Fundus photograph cropped around the optic nerve head. Captured on a Topcon TRC retinal camera. Image size 478x478: 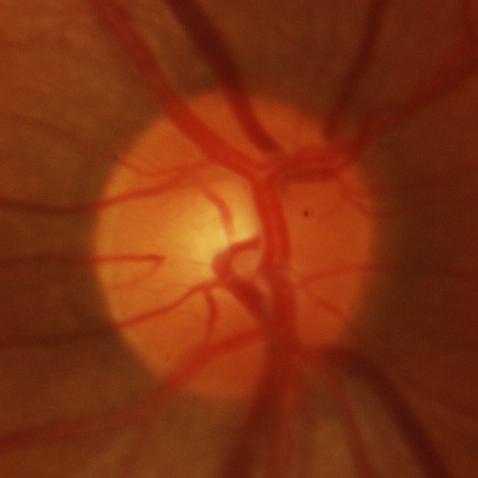
Glaucoma diagnosis = glaucomatous damage to the optic nerve.